Modified Davis grading; acquired with a NIDEK AFC-230; 848x848px; nonmydriatic fundus photograph; 45° field of view
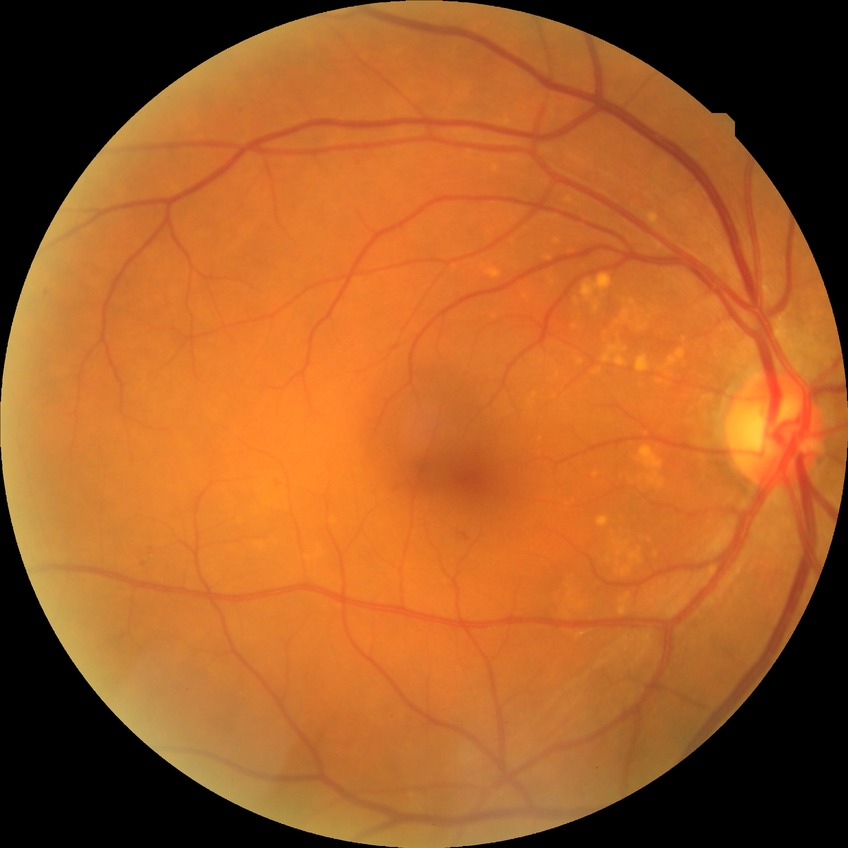

modified Davis classification: simple diabetic retinopathy.